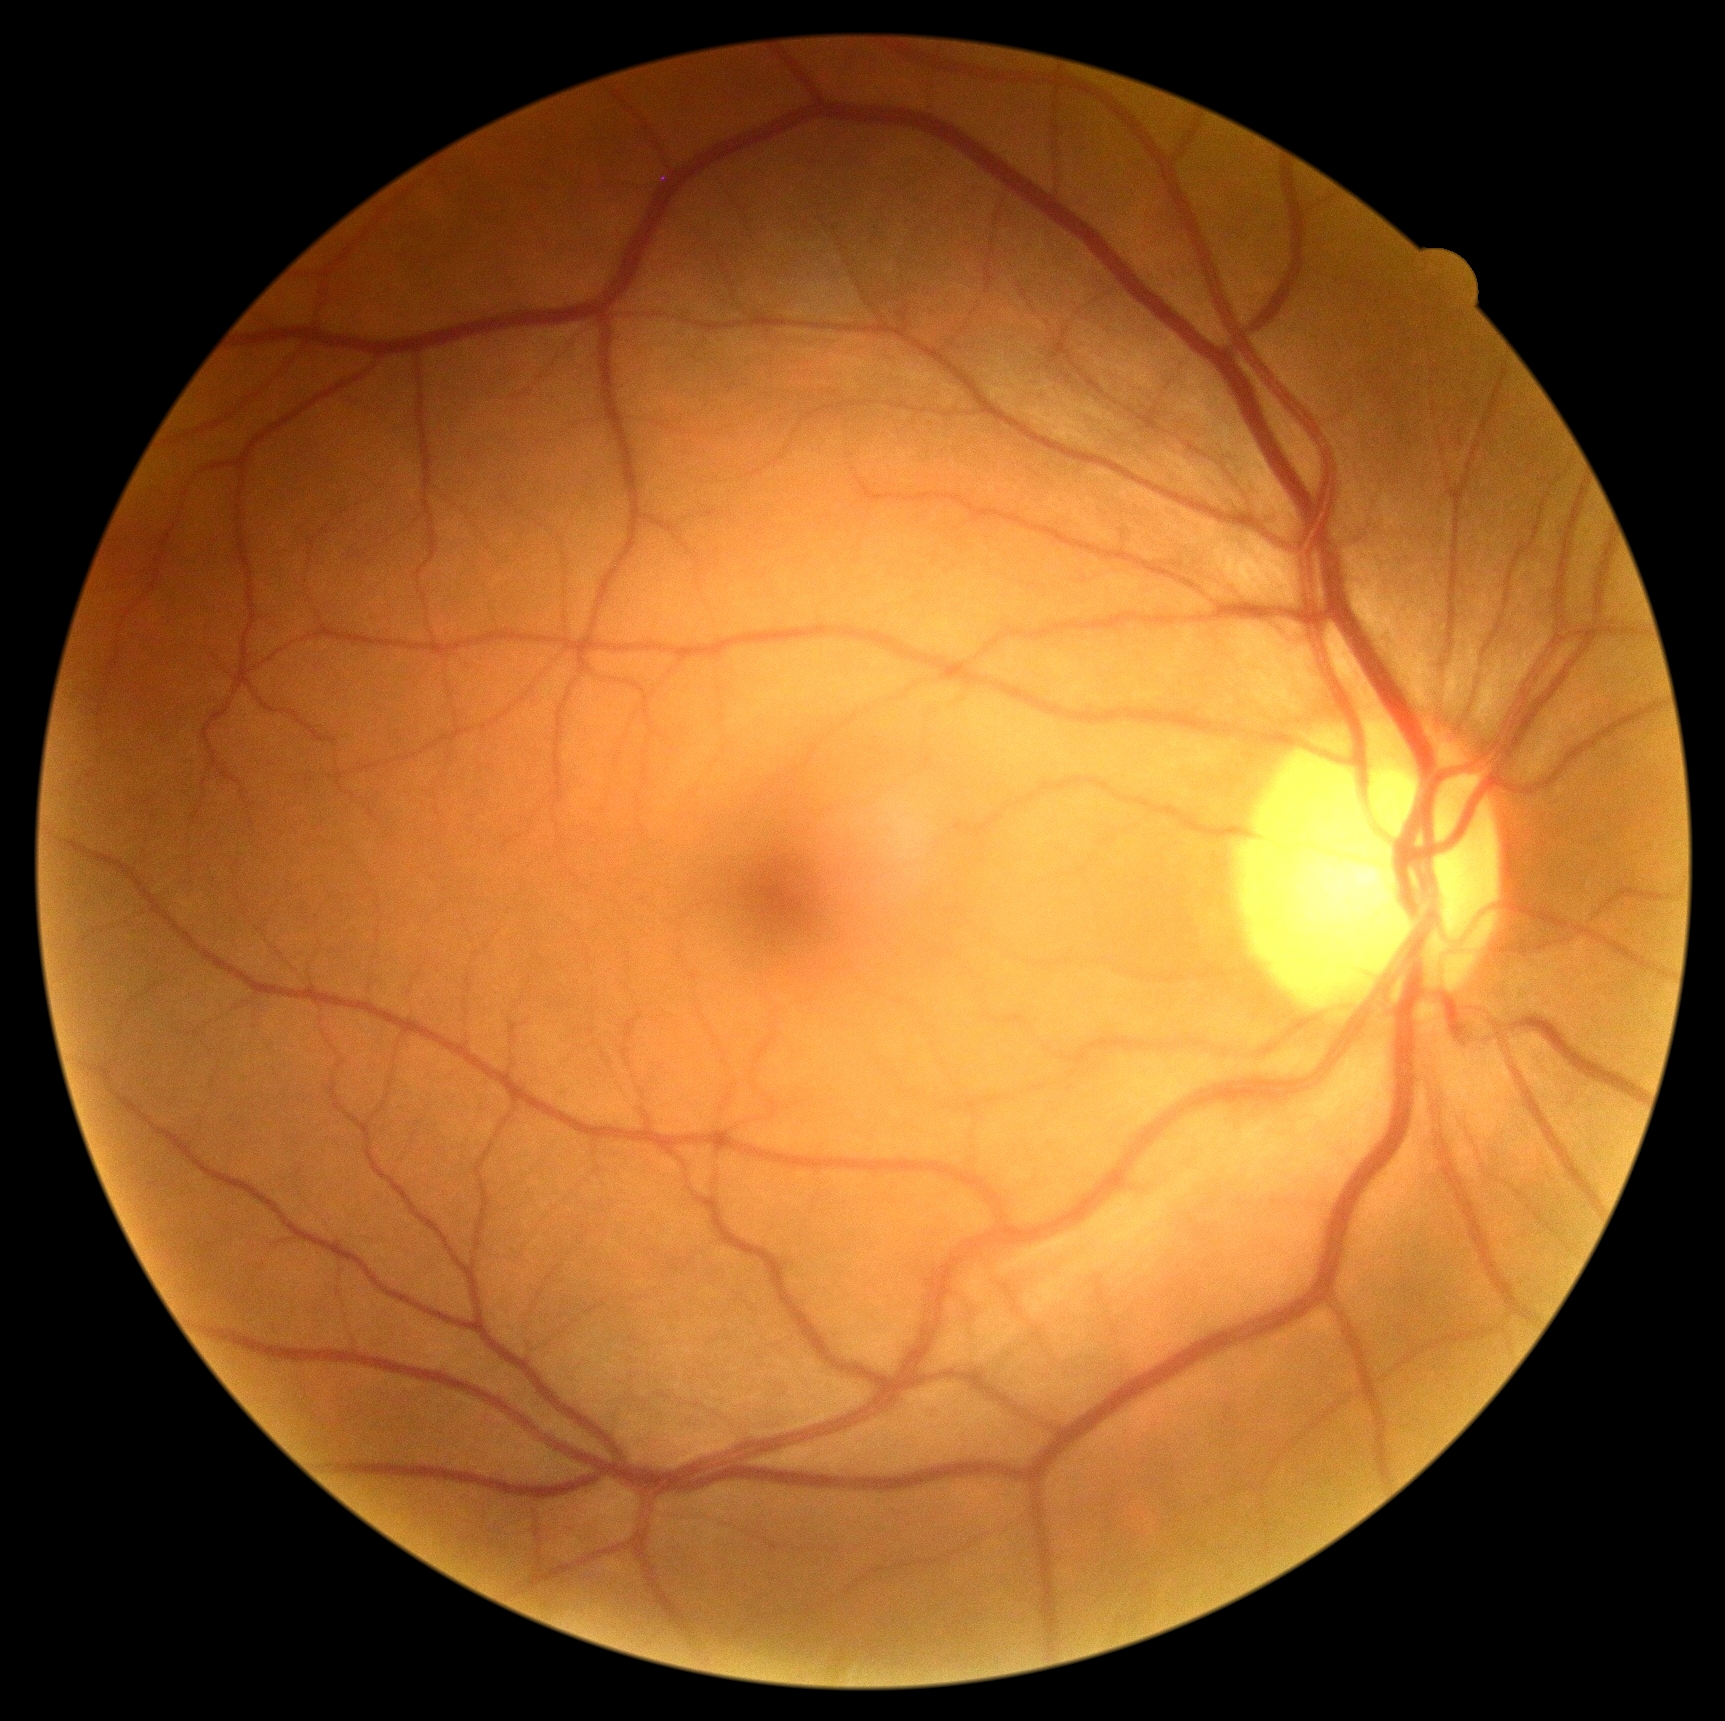 Retinopathy grade: 0 (no apparent retinopathy).